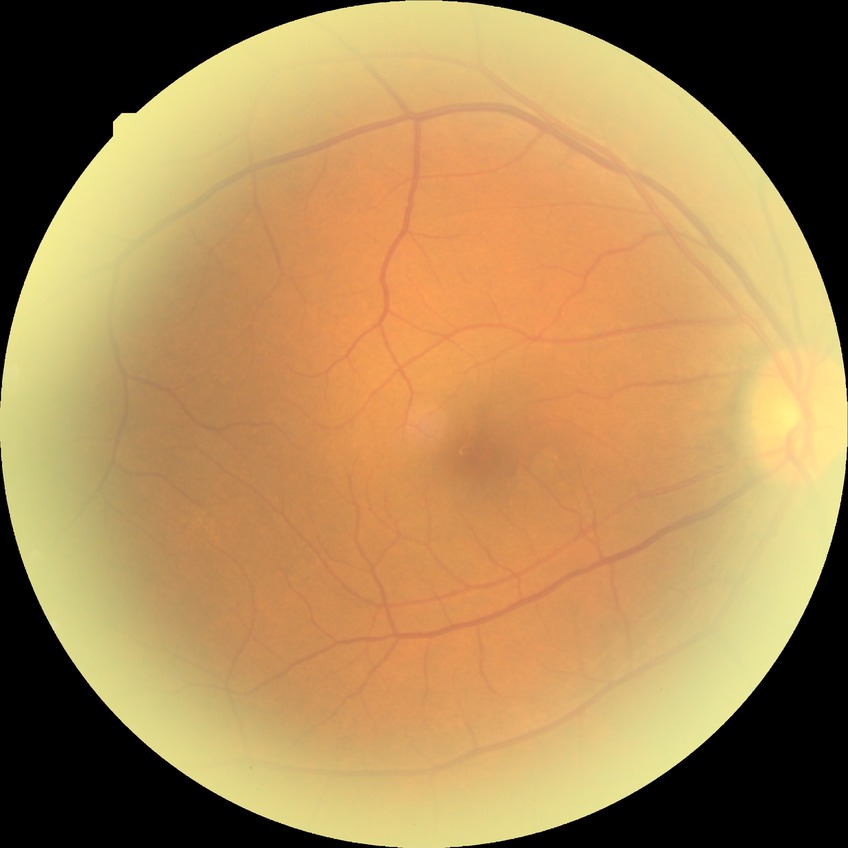
diabetic retinopathy (DR): no diabetic retinopathy (NDR).